Camera: Natus RetCam Envision (130° FOV); image size 1440x1080; wide-field fundus image from infant ROP screening: 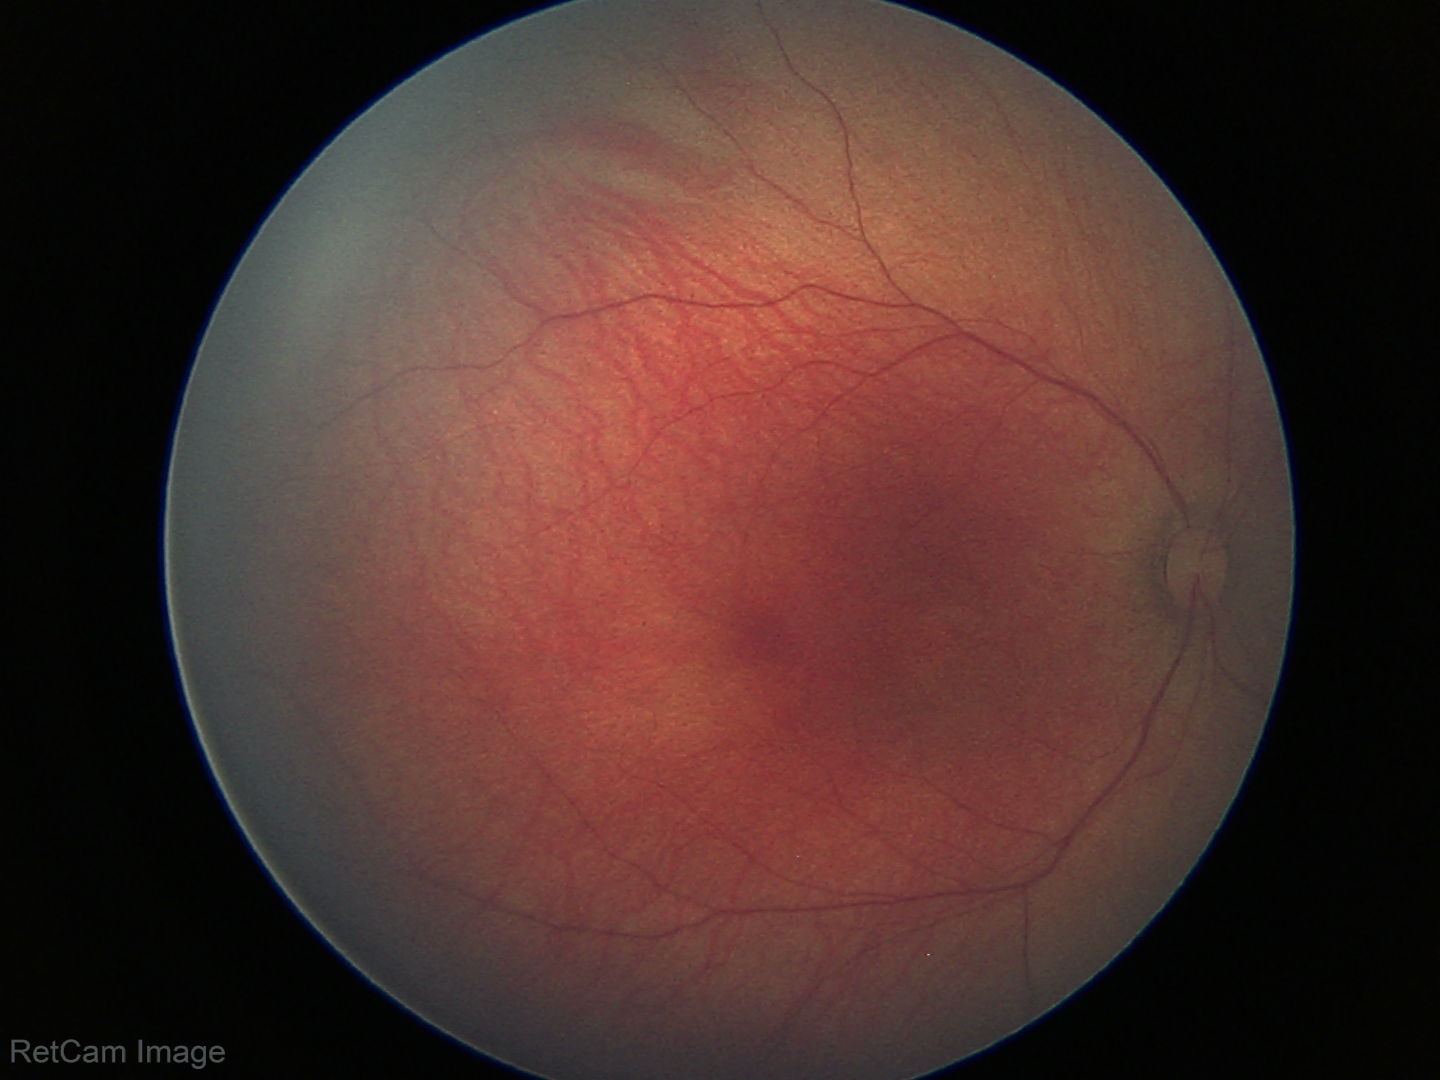 Screening examination diagnosed as physiological.